Infant wide-field fundus photograph; 1240x1240; captured with the Phoenix ICON (100° field of view): 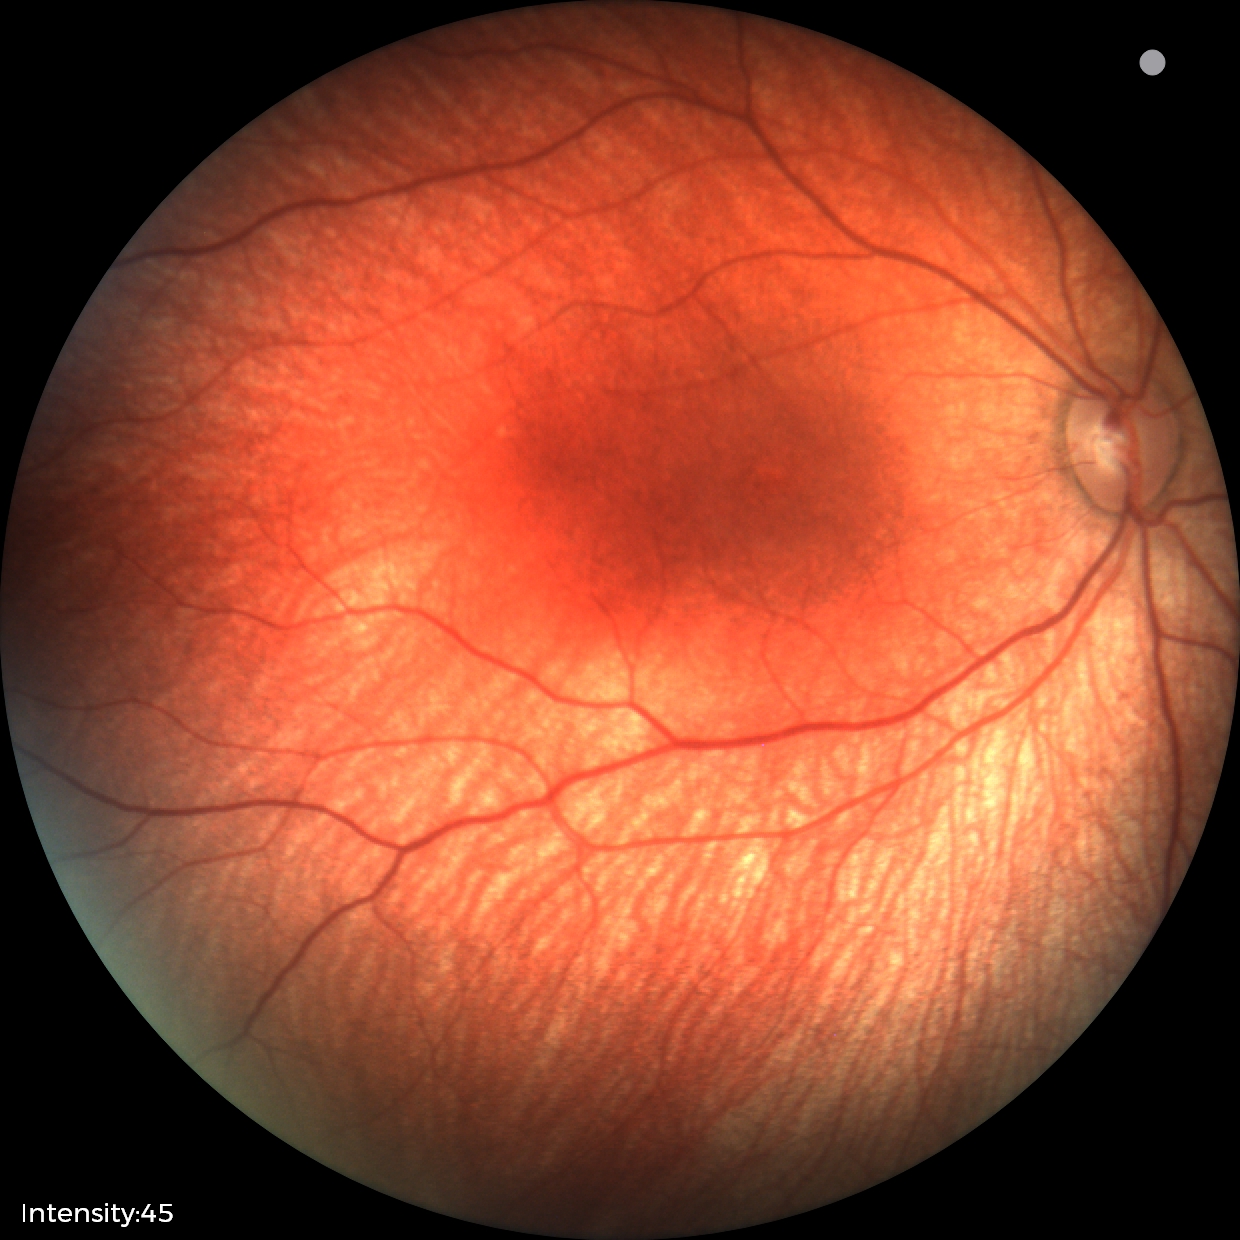
Normal screening examination.